Pediatric retinal photograph (wide-field); image size 640x480; Clarity RetCam 3, 130° FOV — 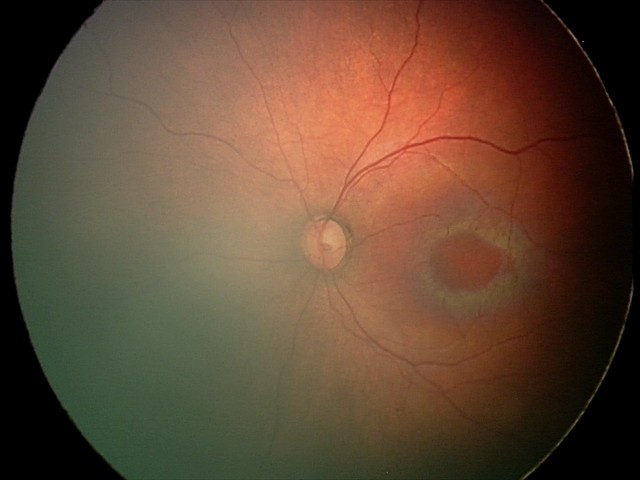

Screening examination diagnosed as physiological.